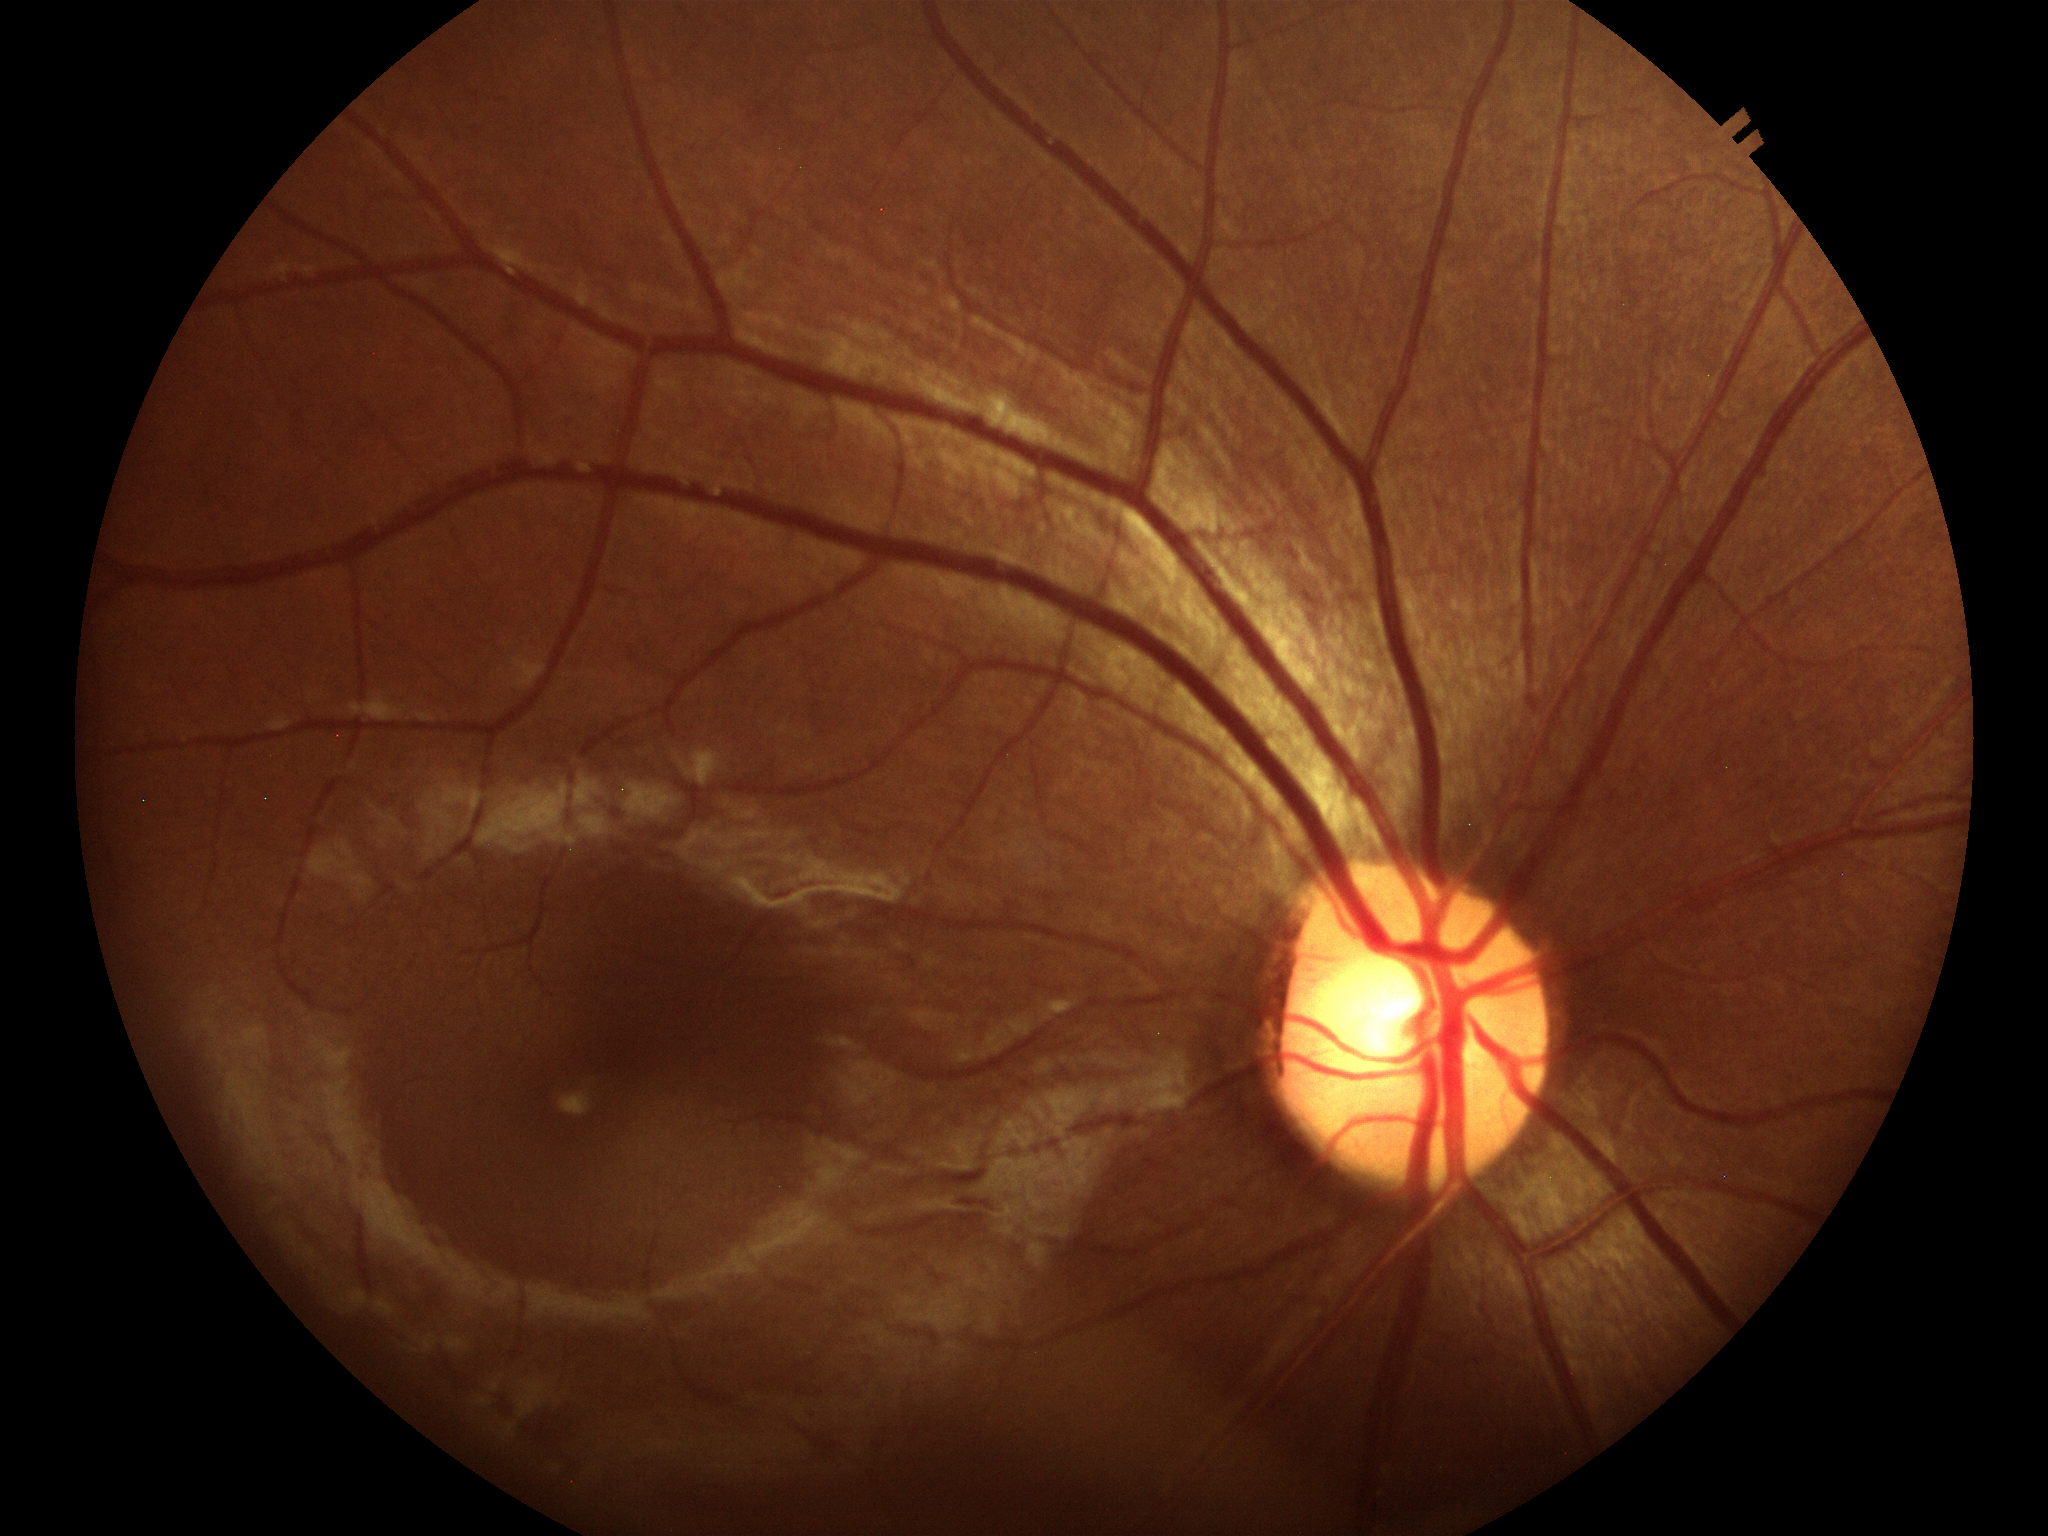 ACDR = 0.29 | Glaucoma impression = no suspicious findings (unanimous normal call) | VCDR = 0.50 | HCDR = 0.58.